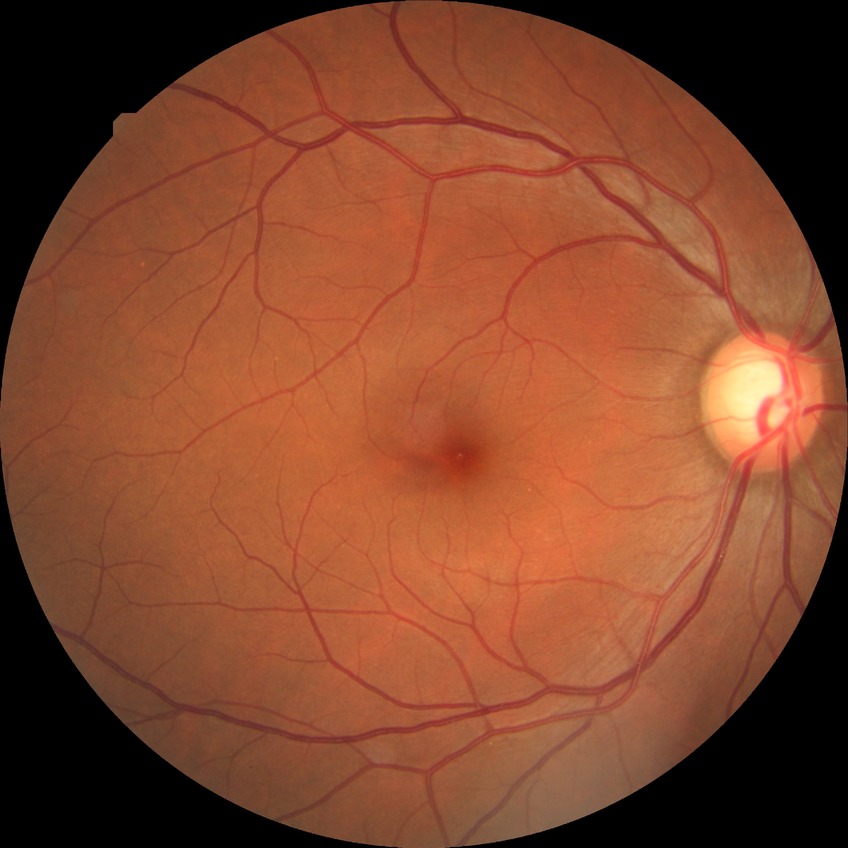

Assessment:
- diabetic retinopathy (DR) — NDR (no diabetic retinopathy)